Davis DR grading.
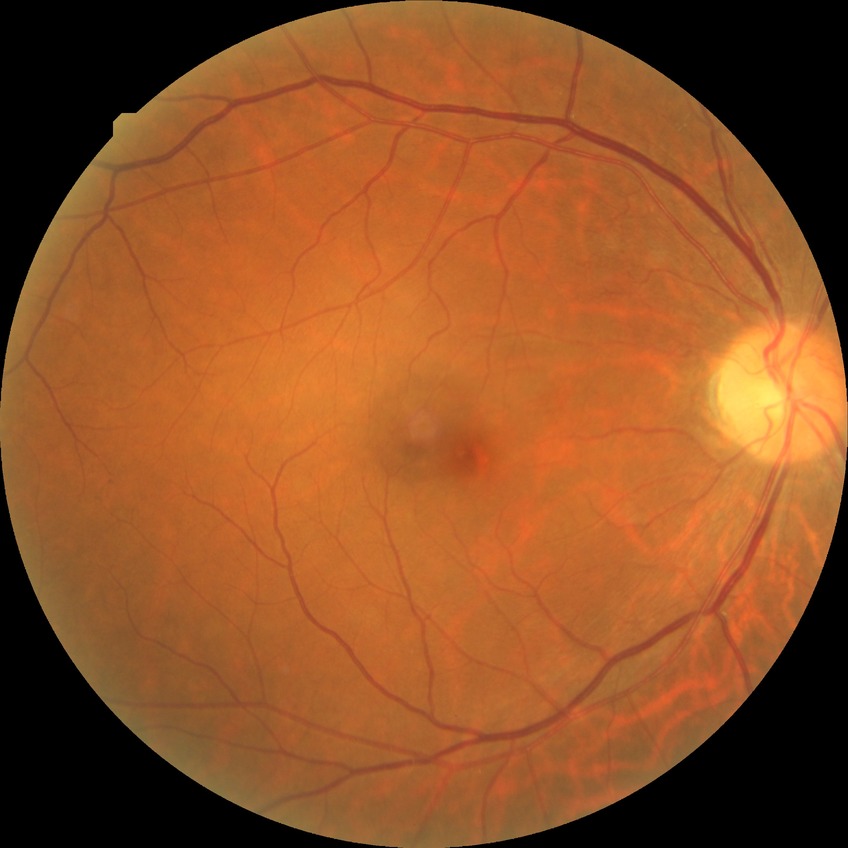 davis_grade: no diabetic retinopathy